Fundus photo, 412x310
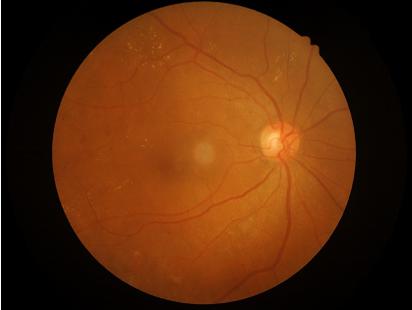

Image is sharp throughout the field.
Image quality is adequate for diagnostic use.